Color fundus photograph · 45-degree field of view · nonmydriatic · camera: NIDEK AFC-230: 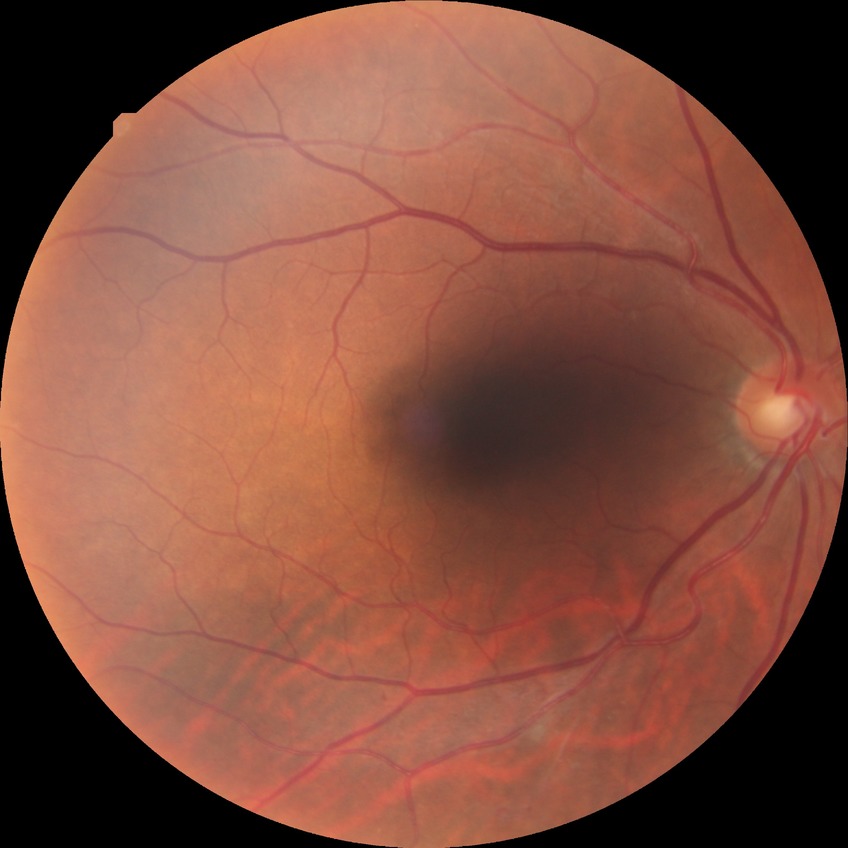 Diabetic retinopathy (DR): simple diabetic retinopathy (SDR).